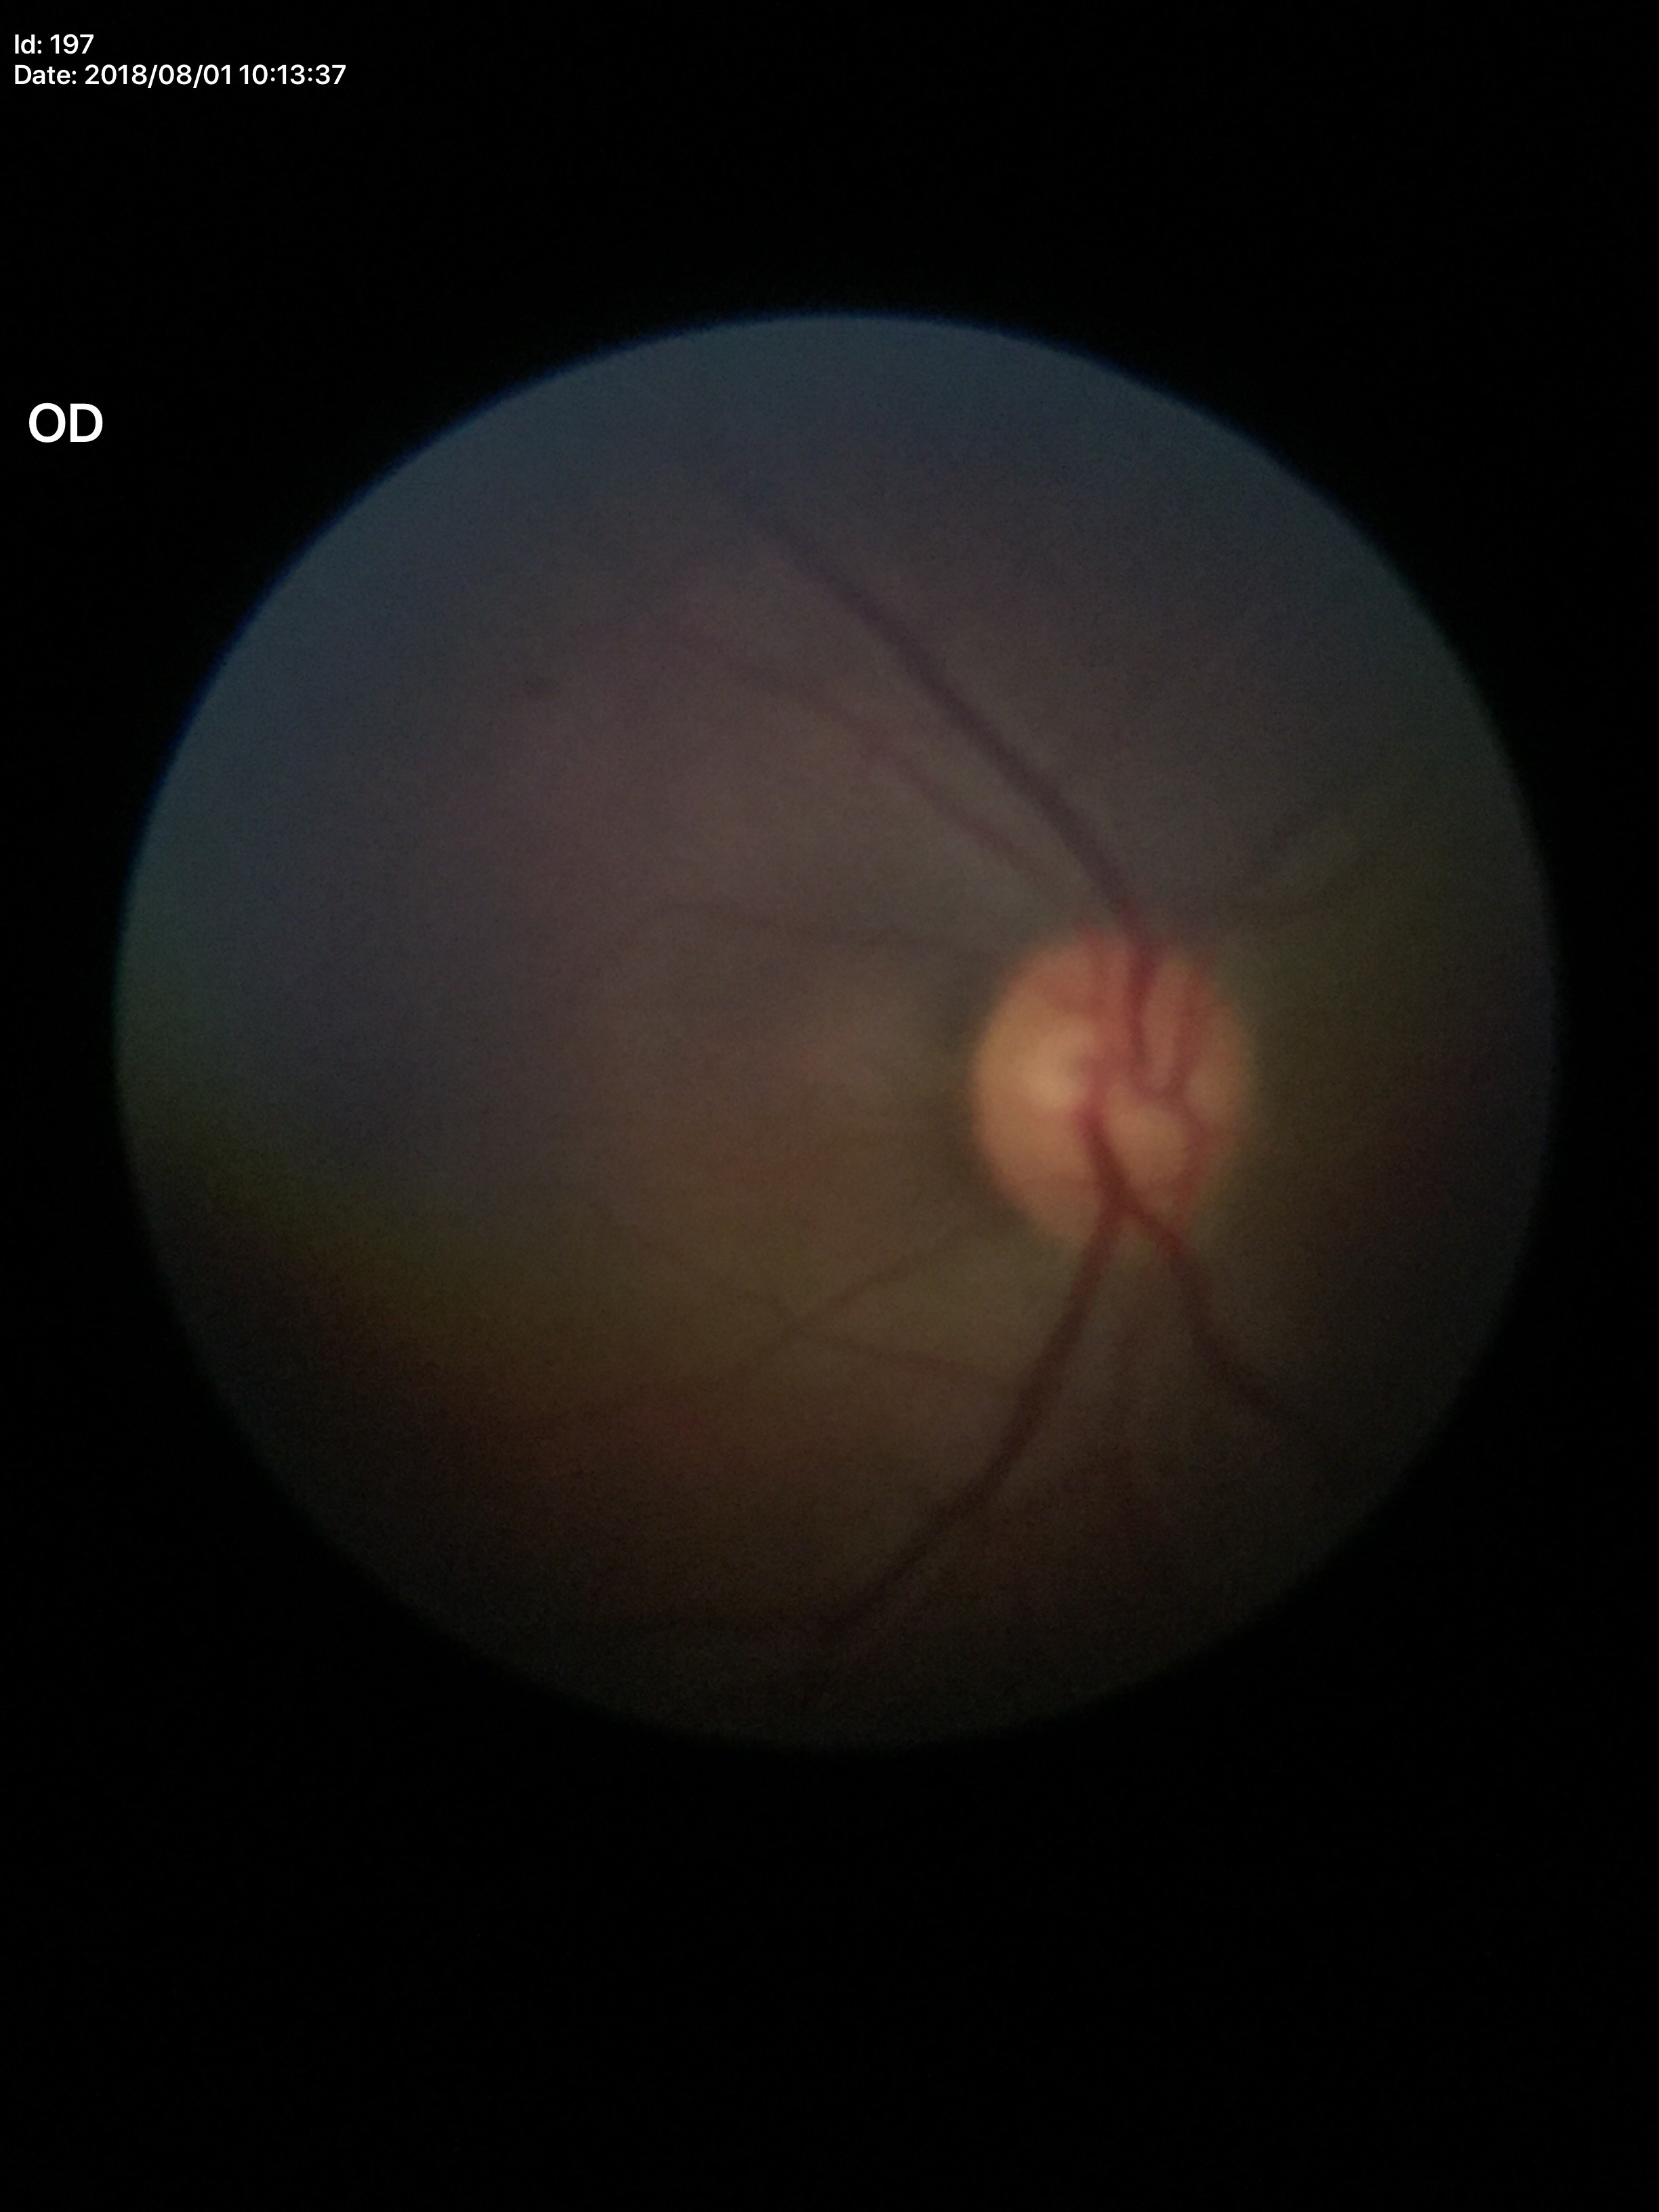

Glaucoma screening impression: no suspicious findings.
Vertical cup-disc ratio of 0.52.